Color fundus image, 2352x1568, 45-degree field of view
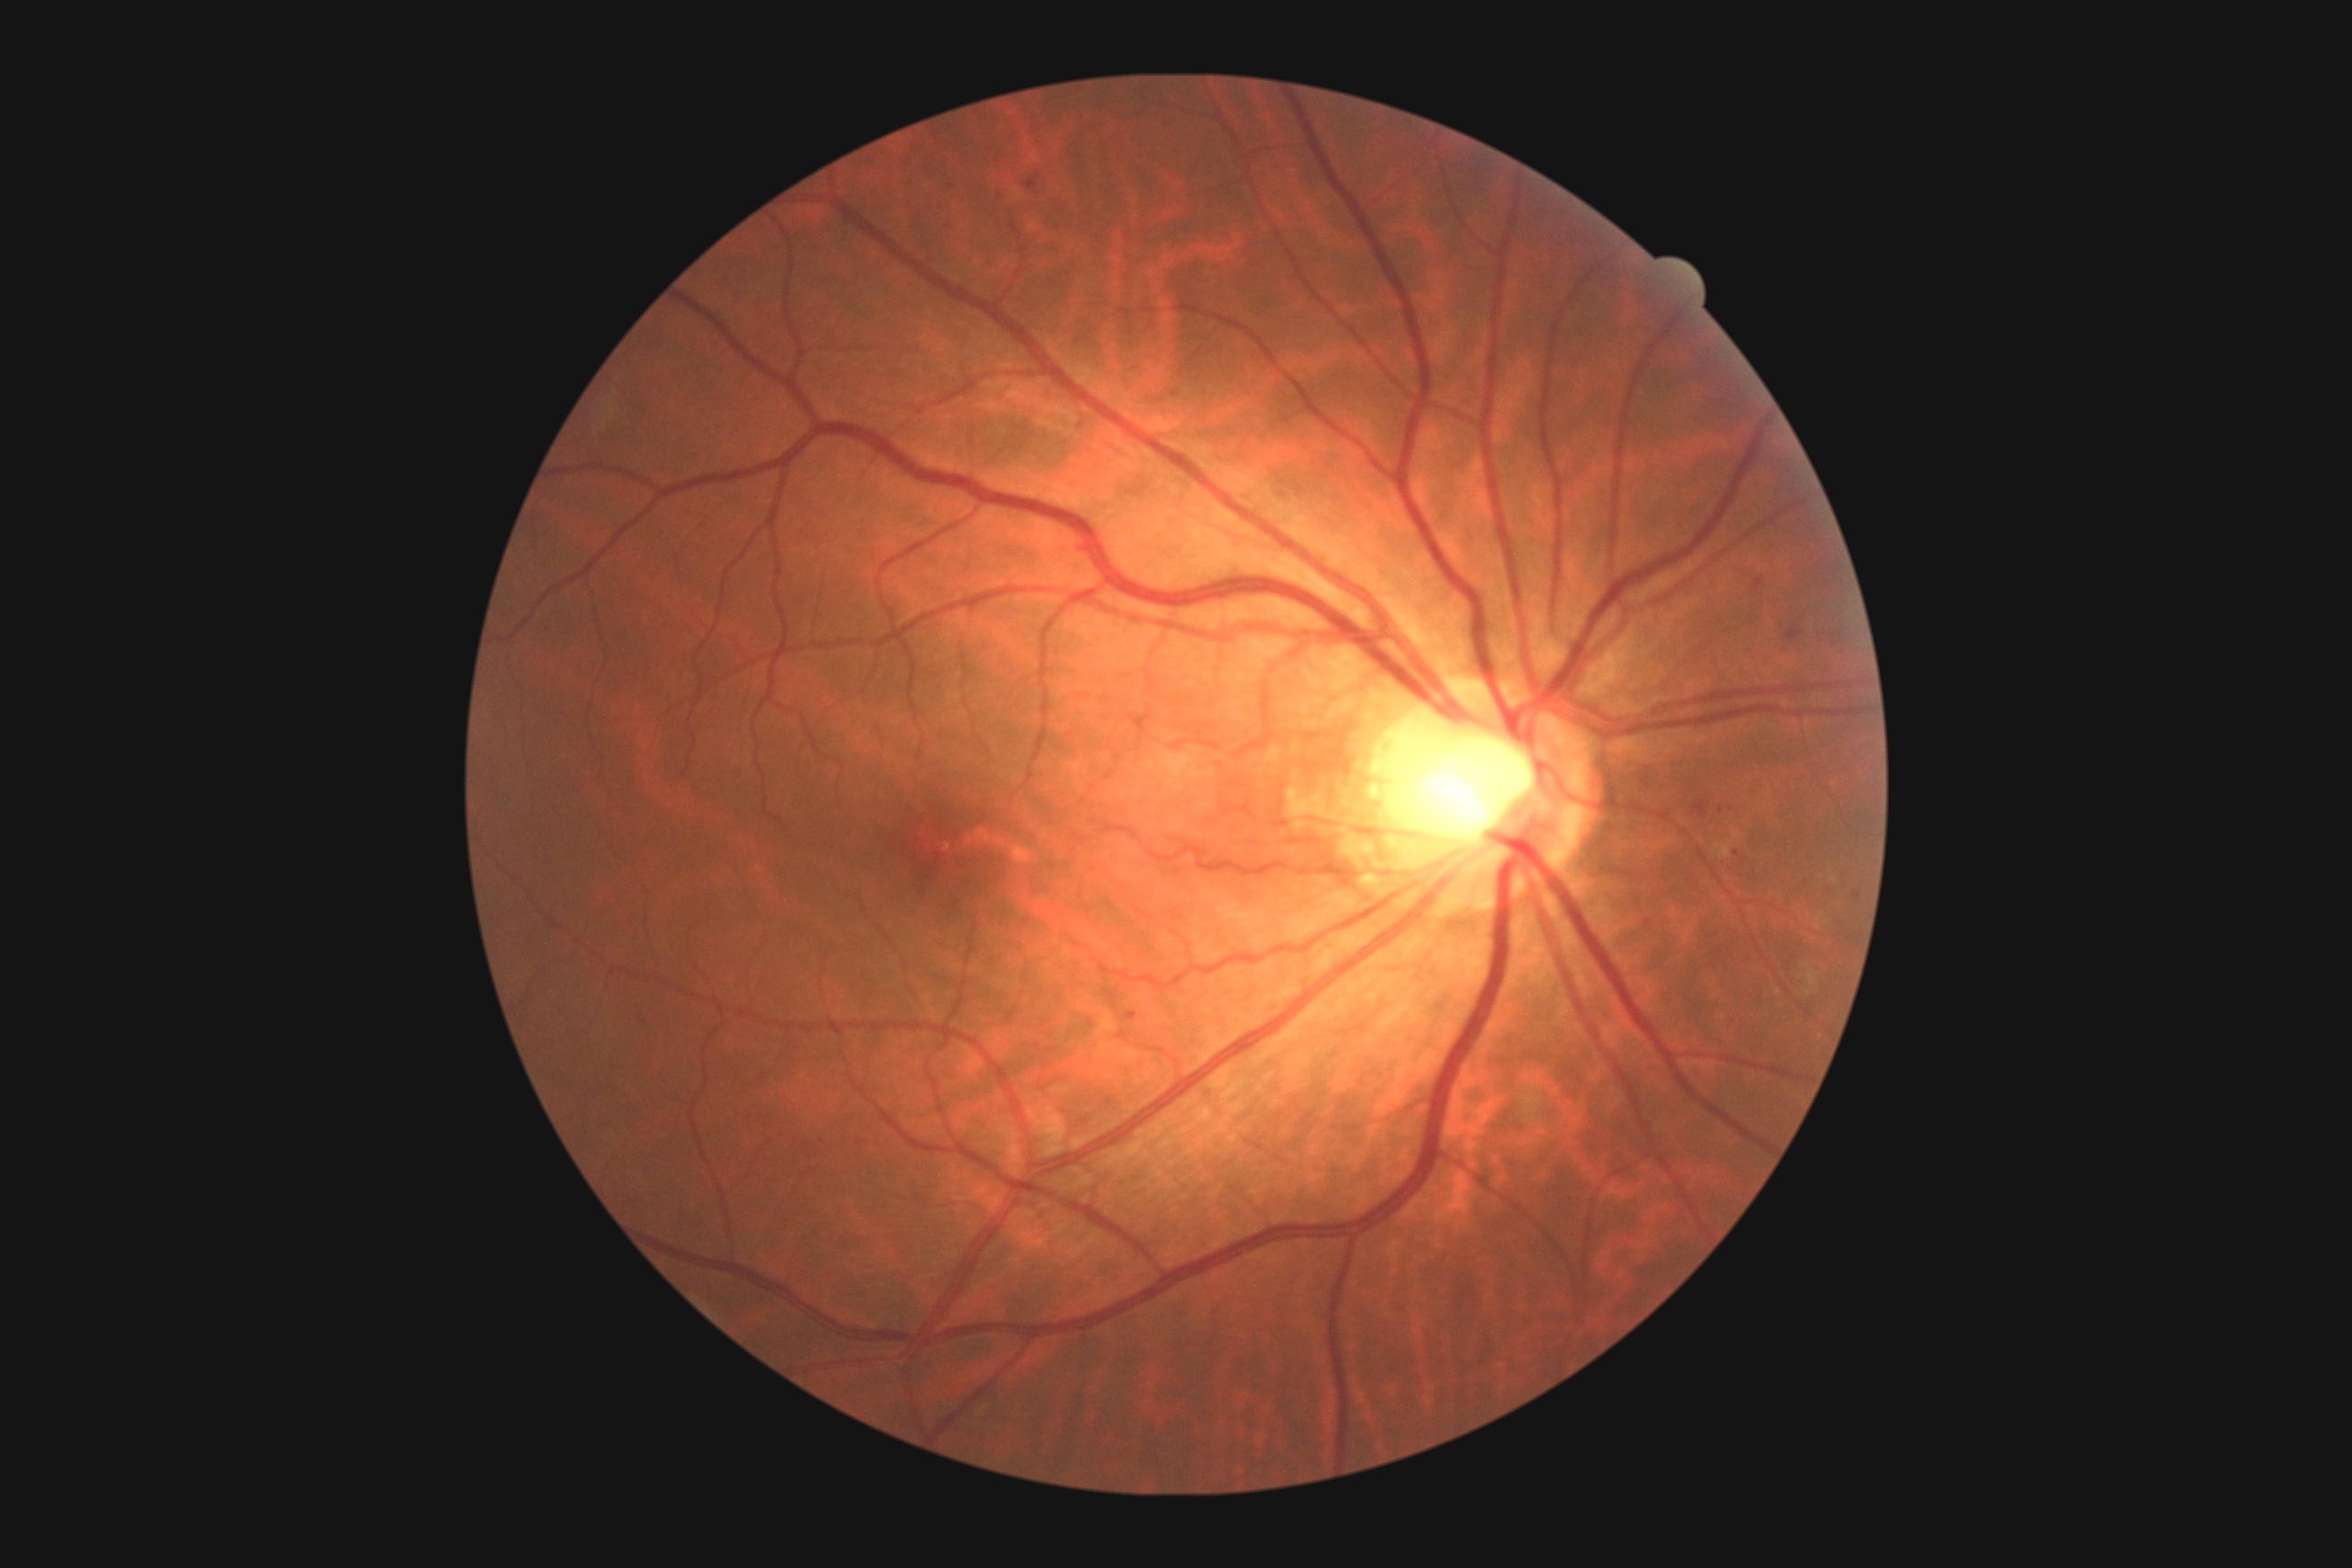 diabetic retinopathy severity: 2.